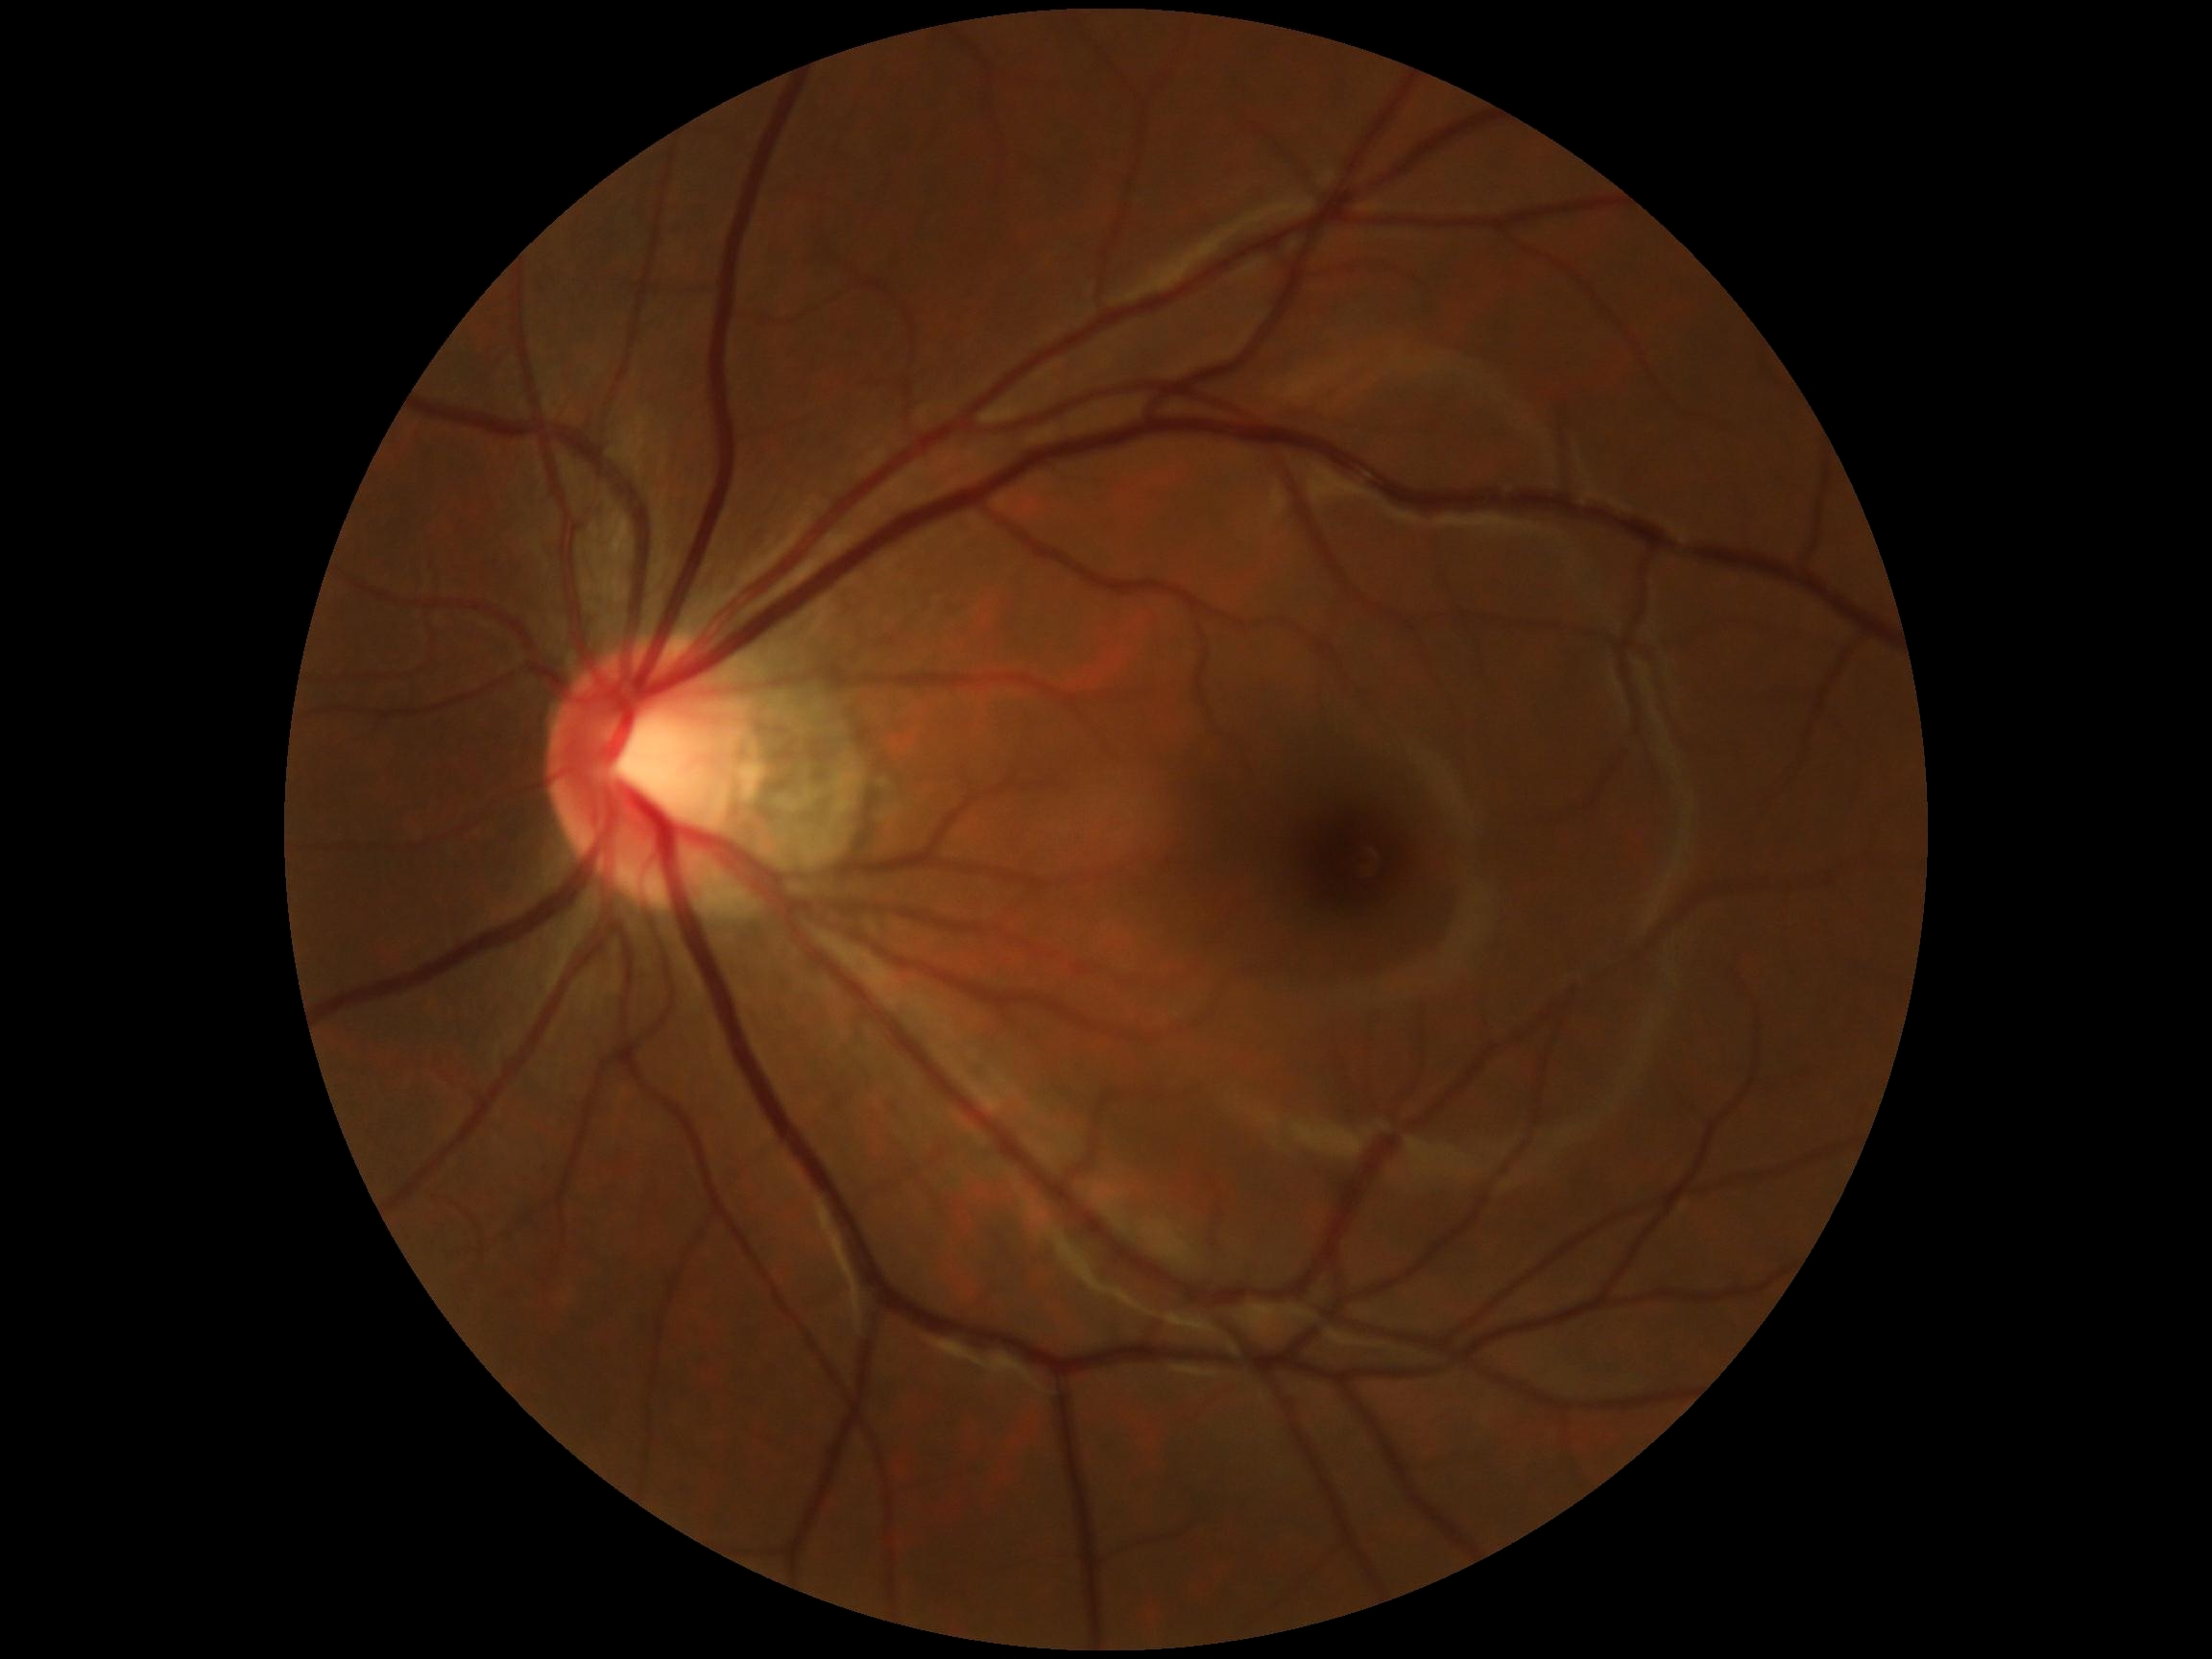 retinopathy = grade 0 (no apparent retinopathy) — no visible signs of diabetic retinopathy; DR impression = no signs of DR.